NIDEK AFC-230 fundus camera · 45-degree field of view · no pharmacologic dilation
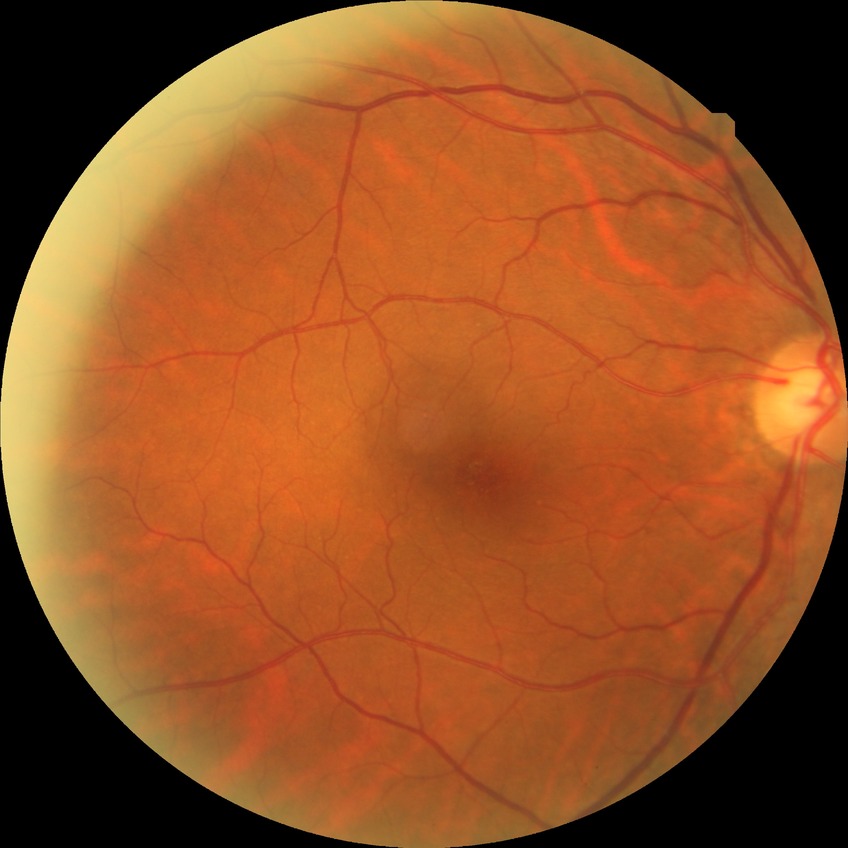   davis_grade: SDR